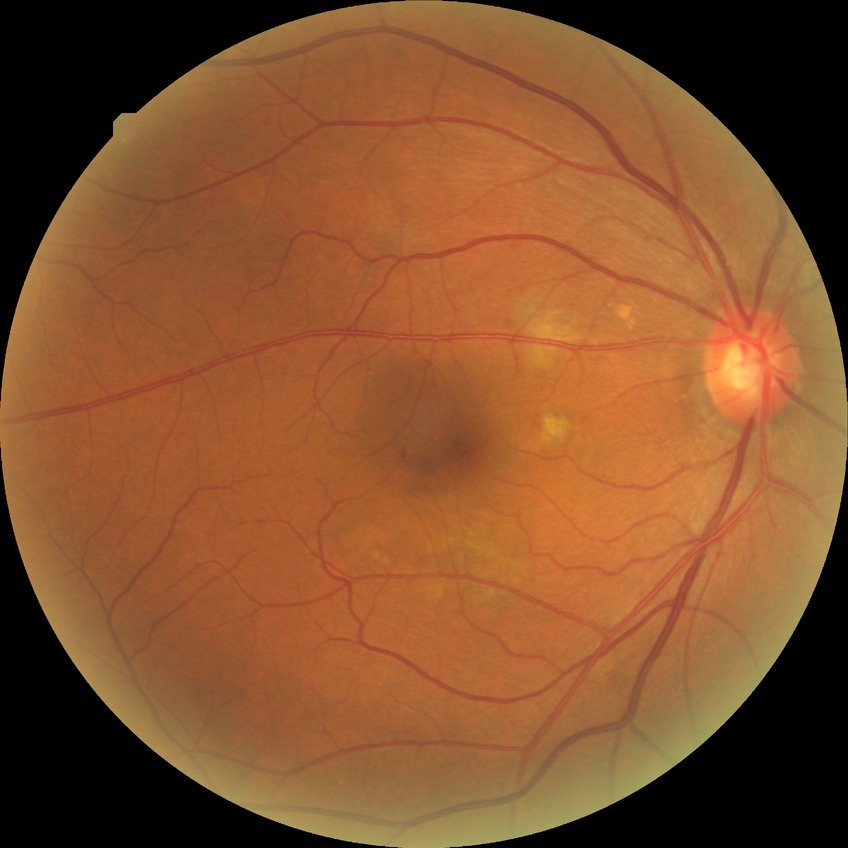 diabetic retinopathy grade: no diabetic retinopathy.